RetCam wide-field infant fundus image.
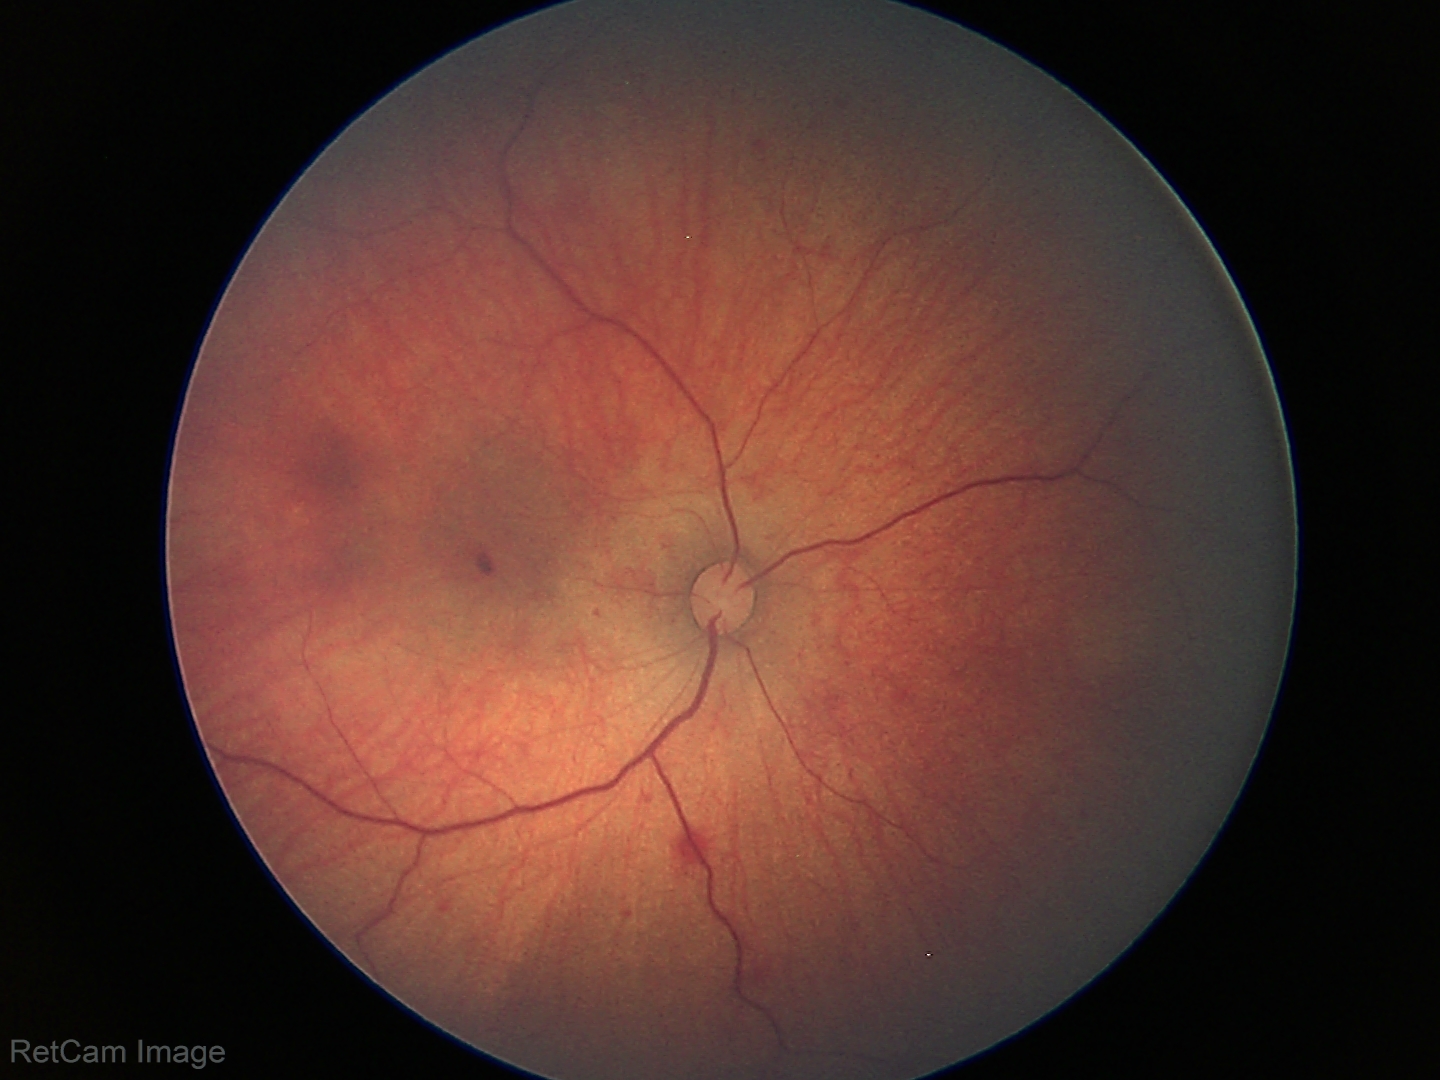

Screening examination consistent with retinal hemorrhages.